Ultra-widefield fundus photograph — 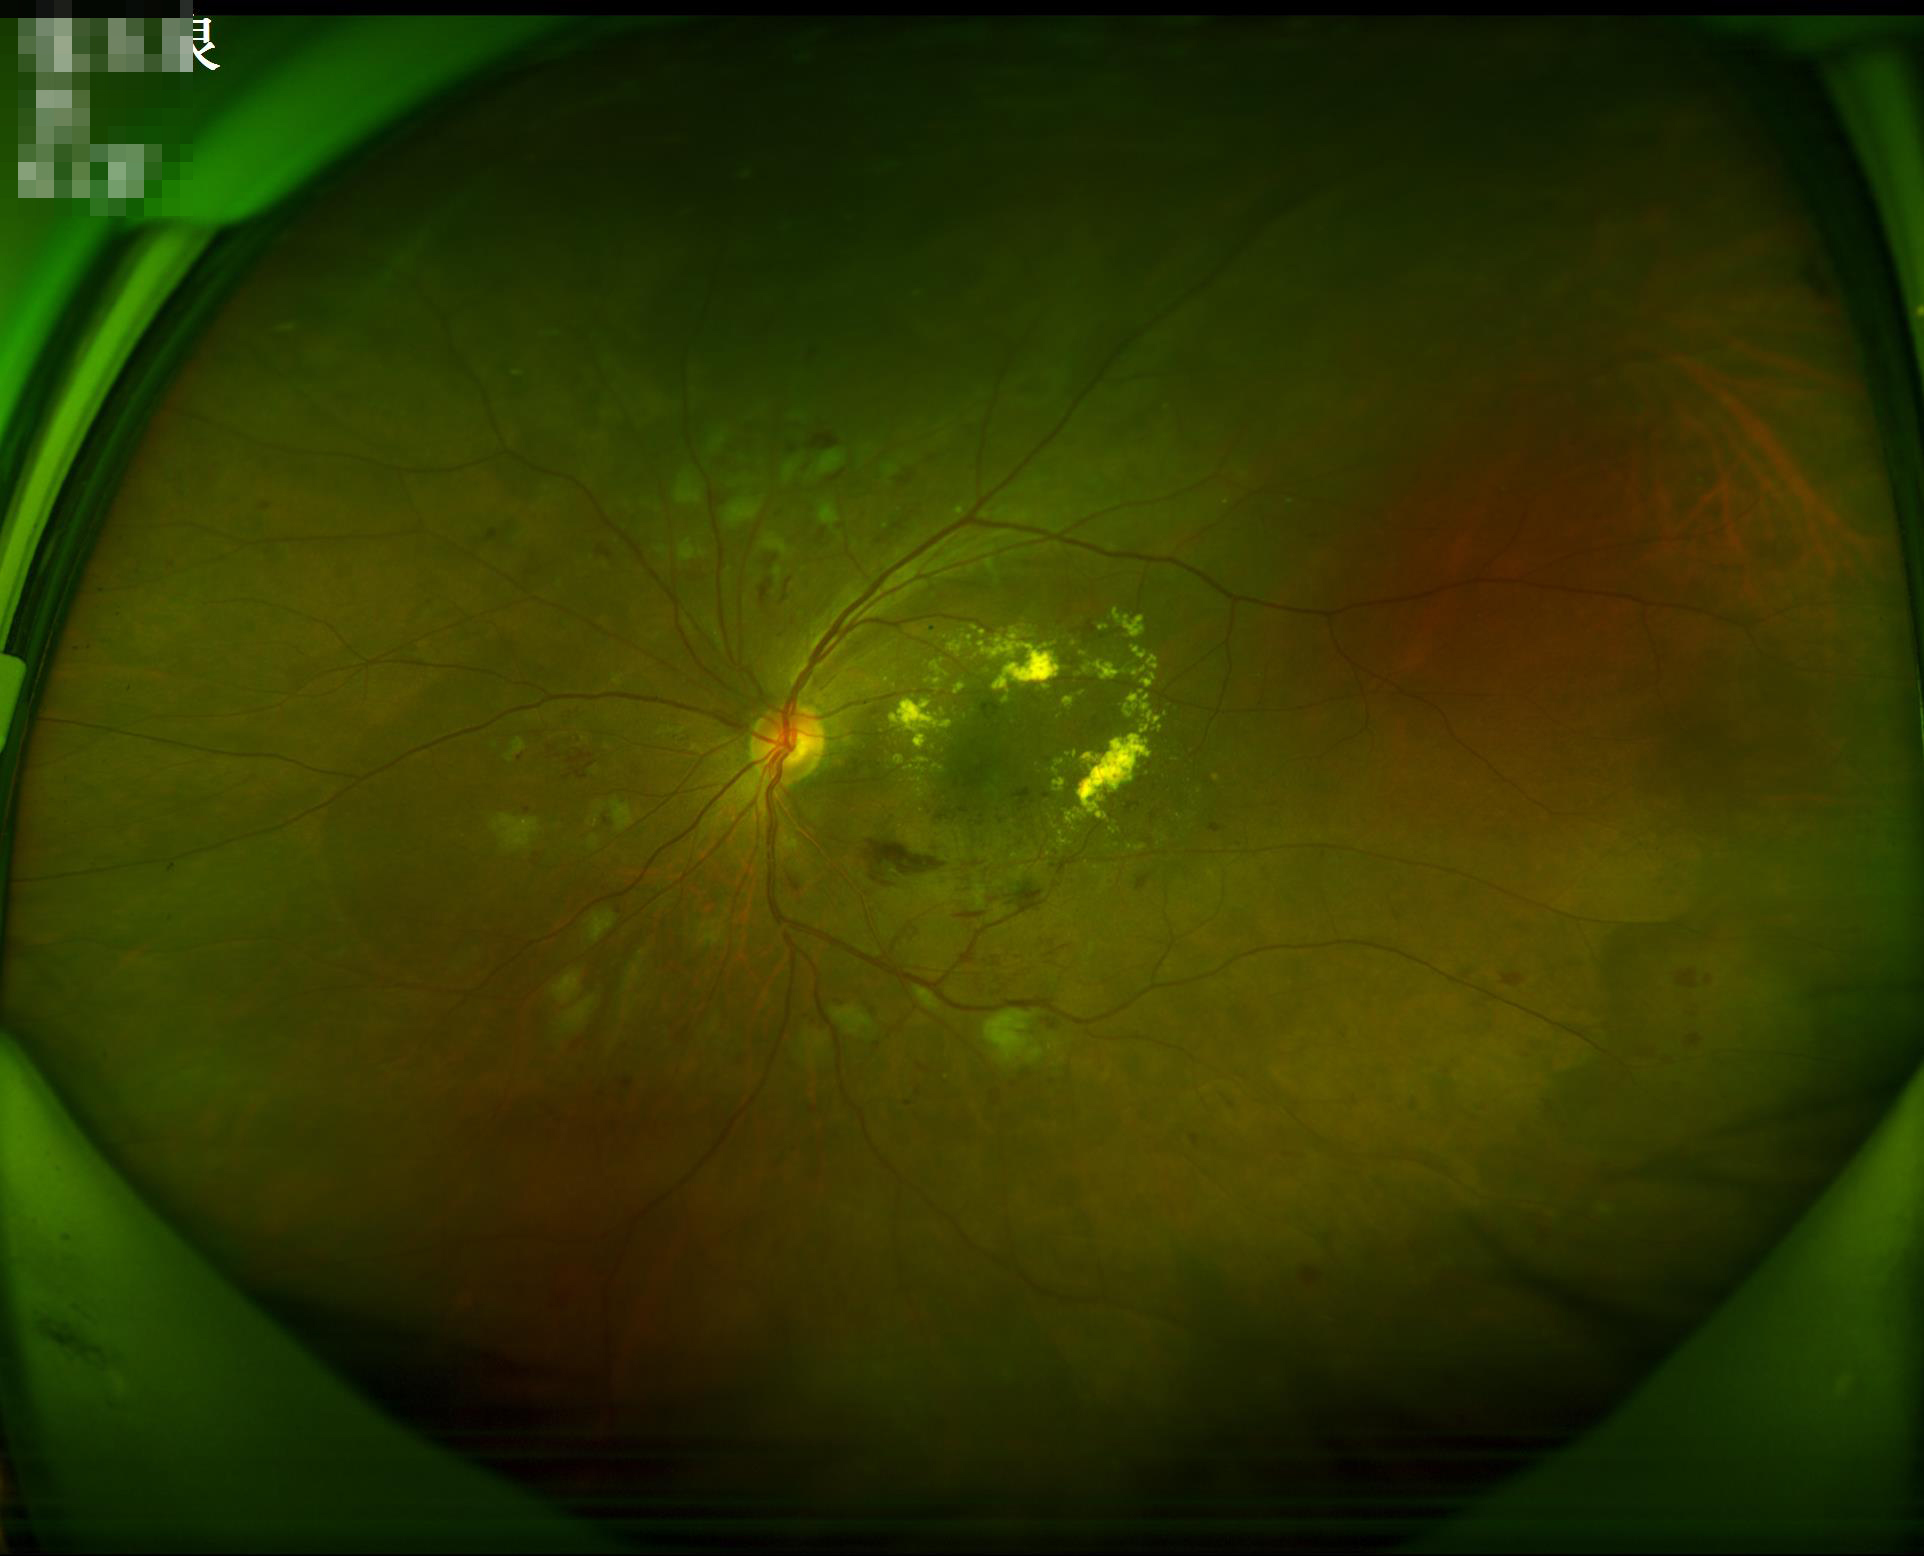 Quality grading:
- illumination/color: even and well-balanced
- contrast: vessels and details readily distinguishable
- overall: adequate for clinical interpretation